1380 by 1382 pixels
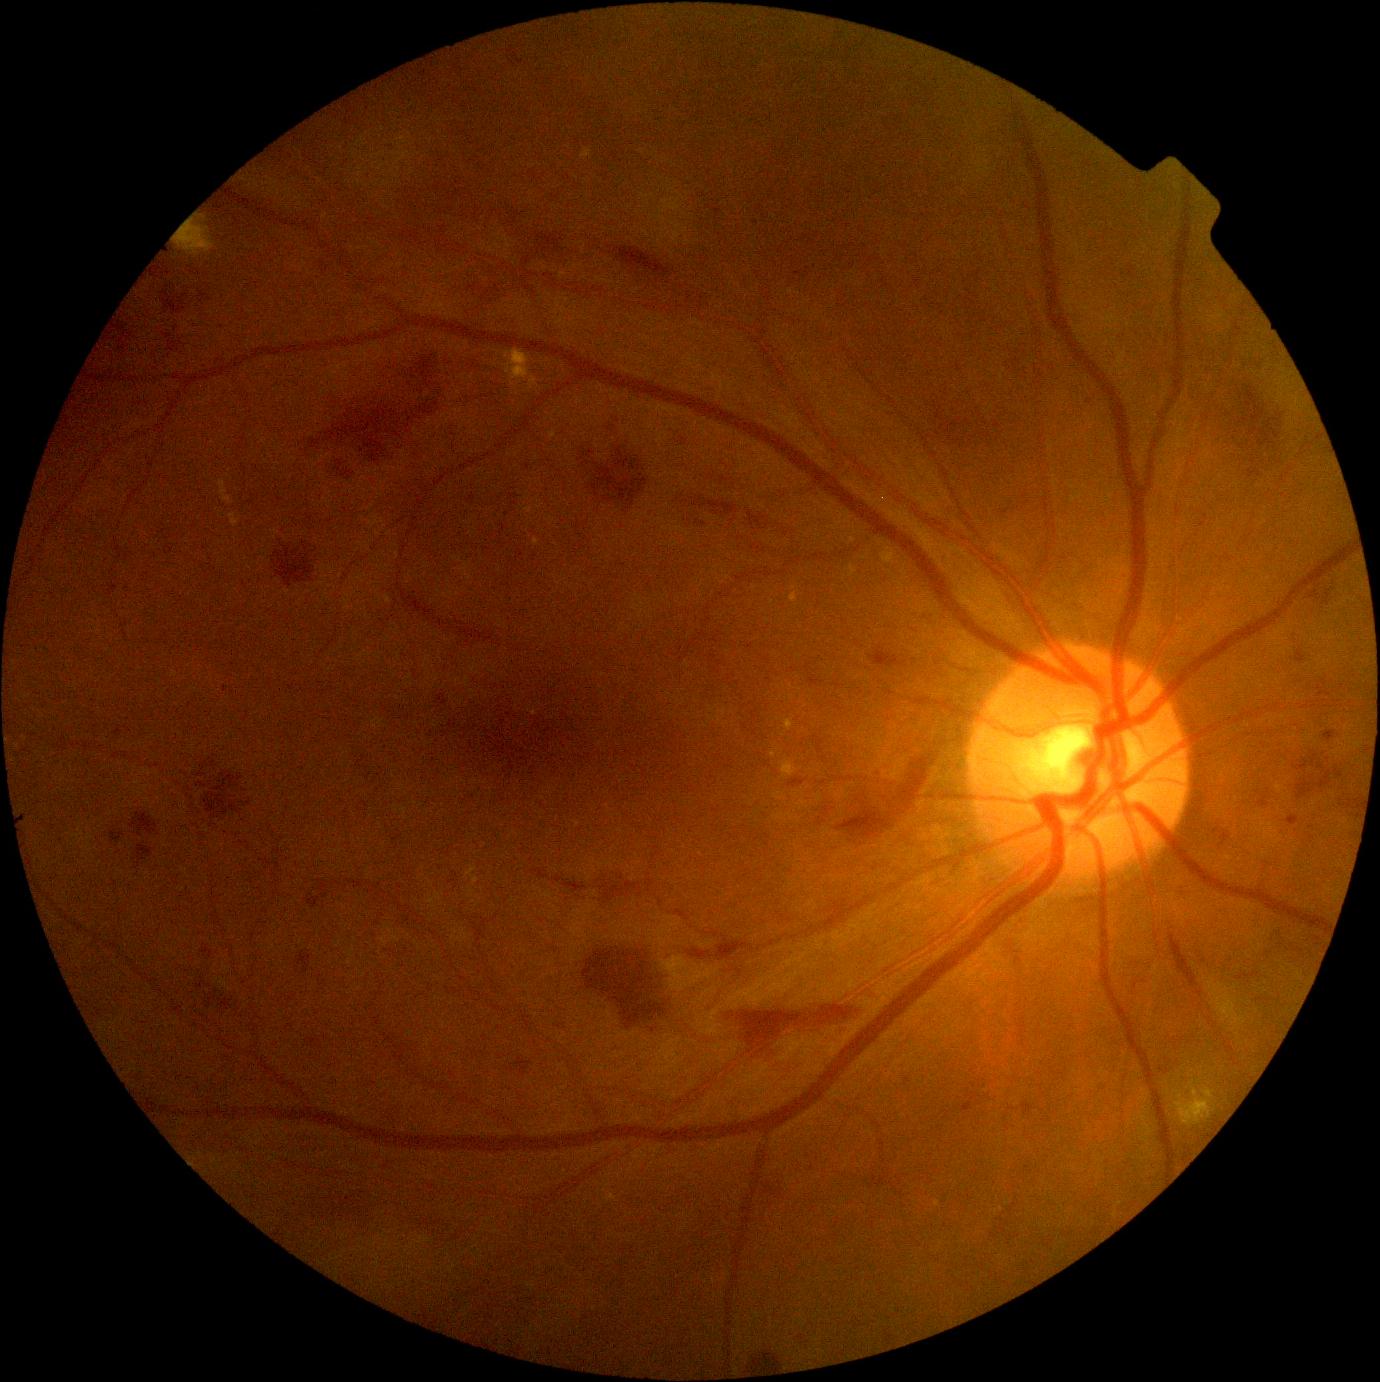
diabetic retinopathy severity@grade 2 (moderate NPDR).